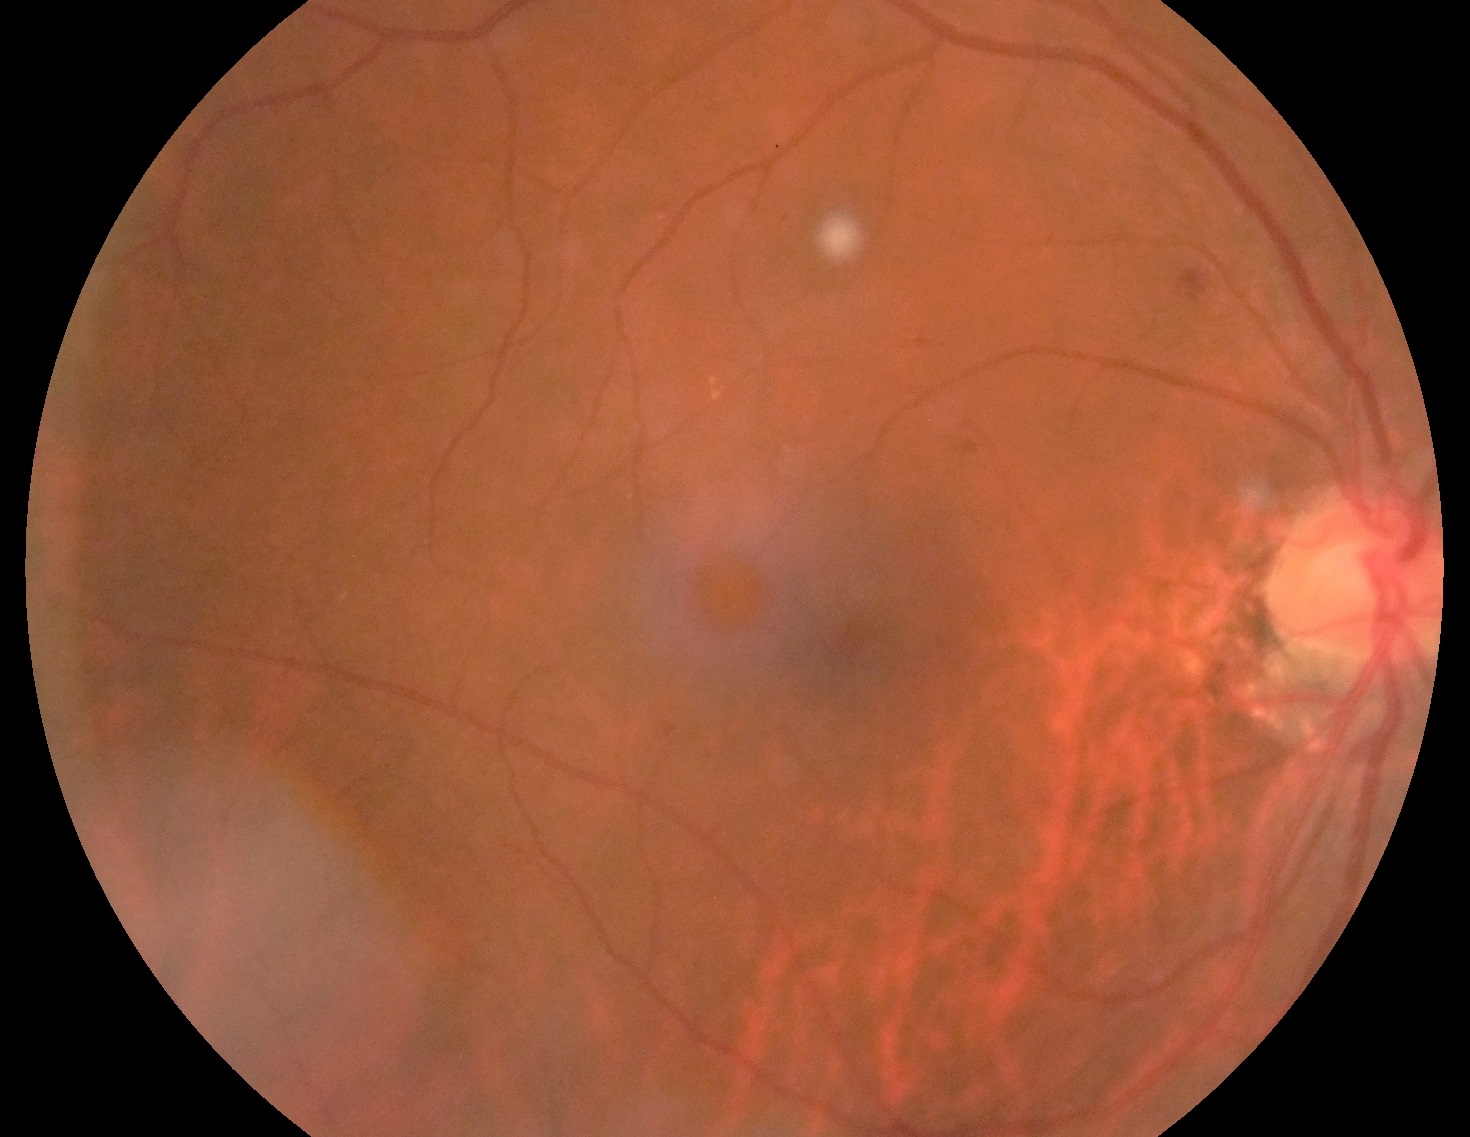

{
  "dr_grade": "2"
}